Color fundus photograph:
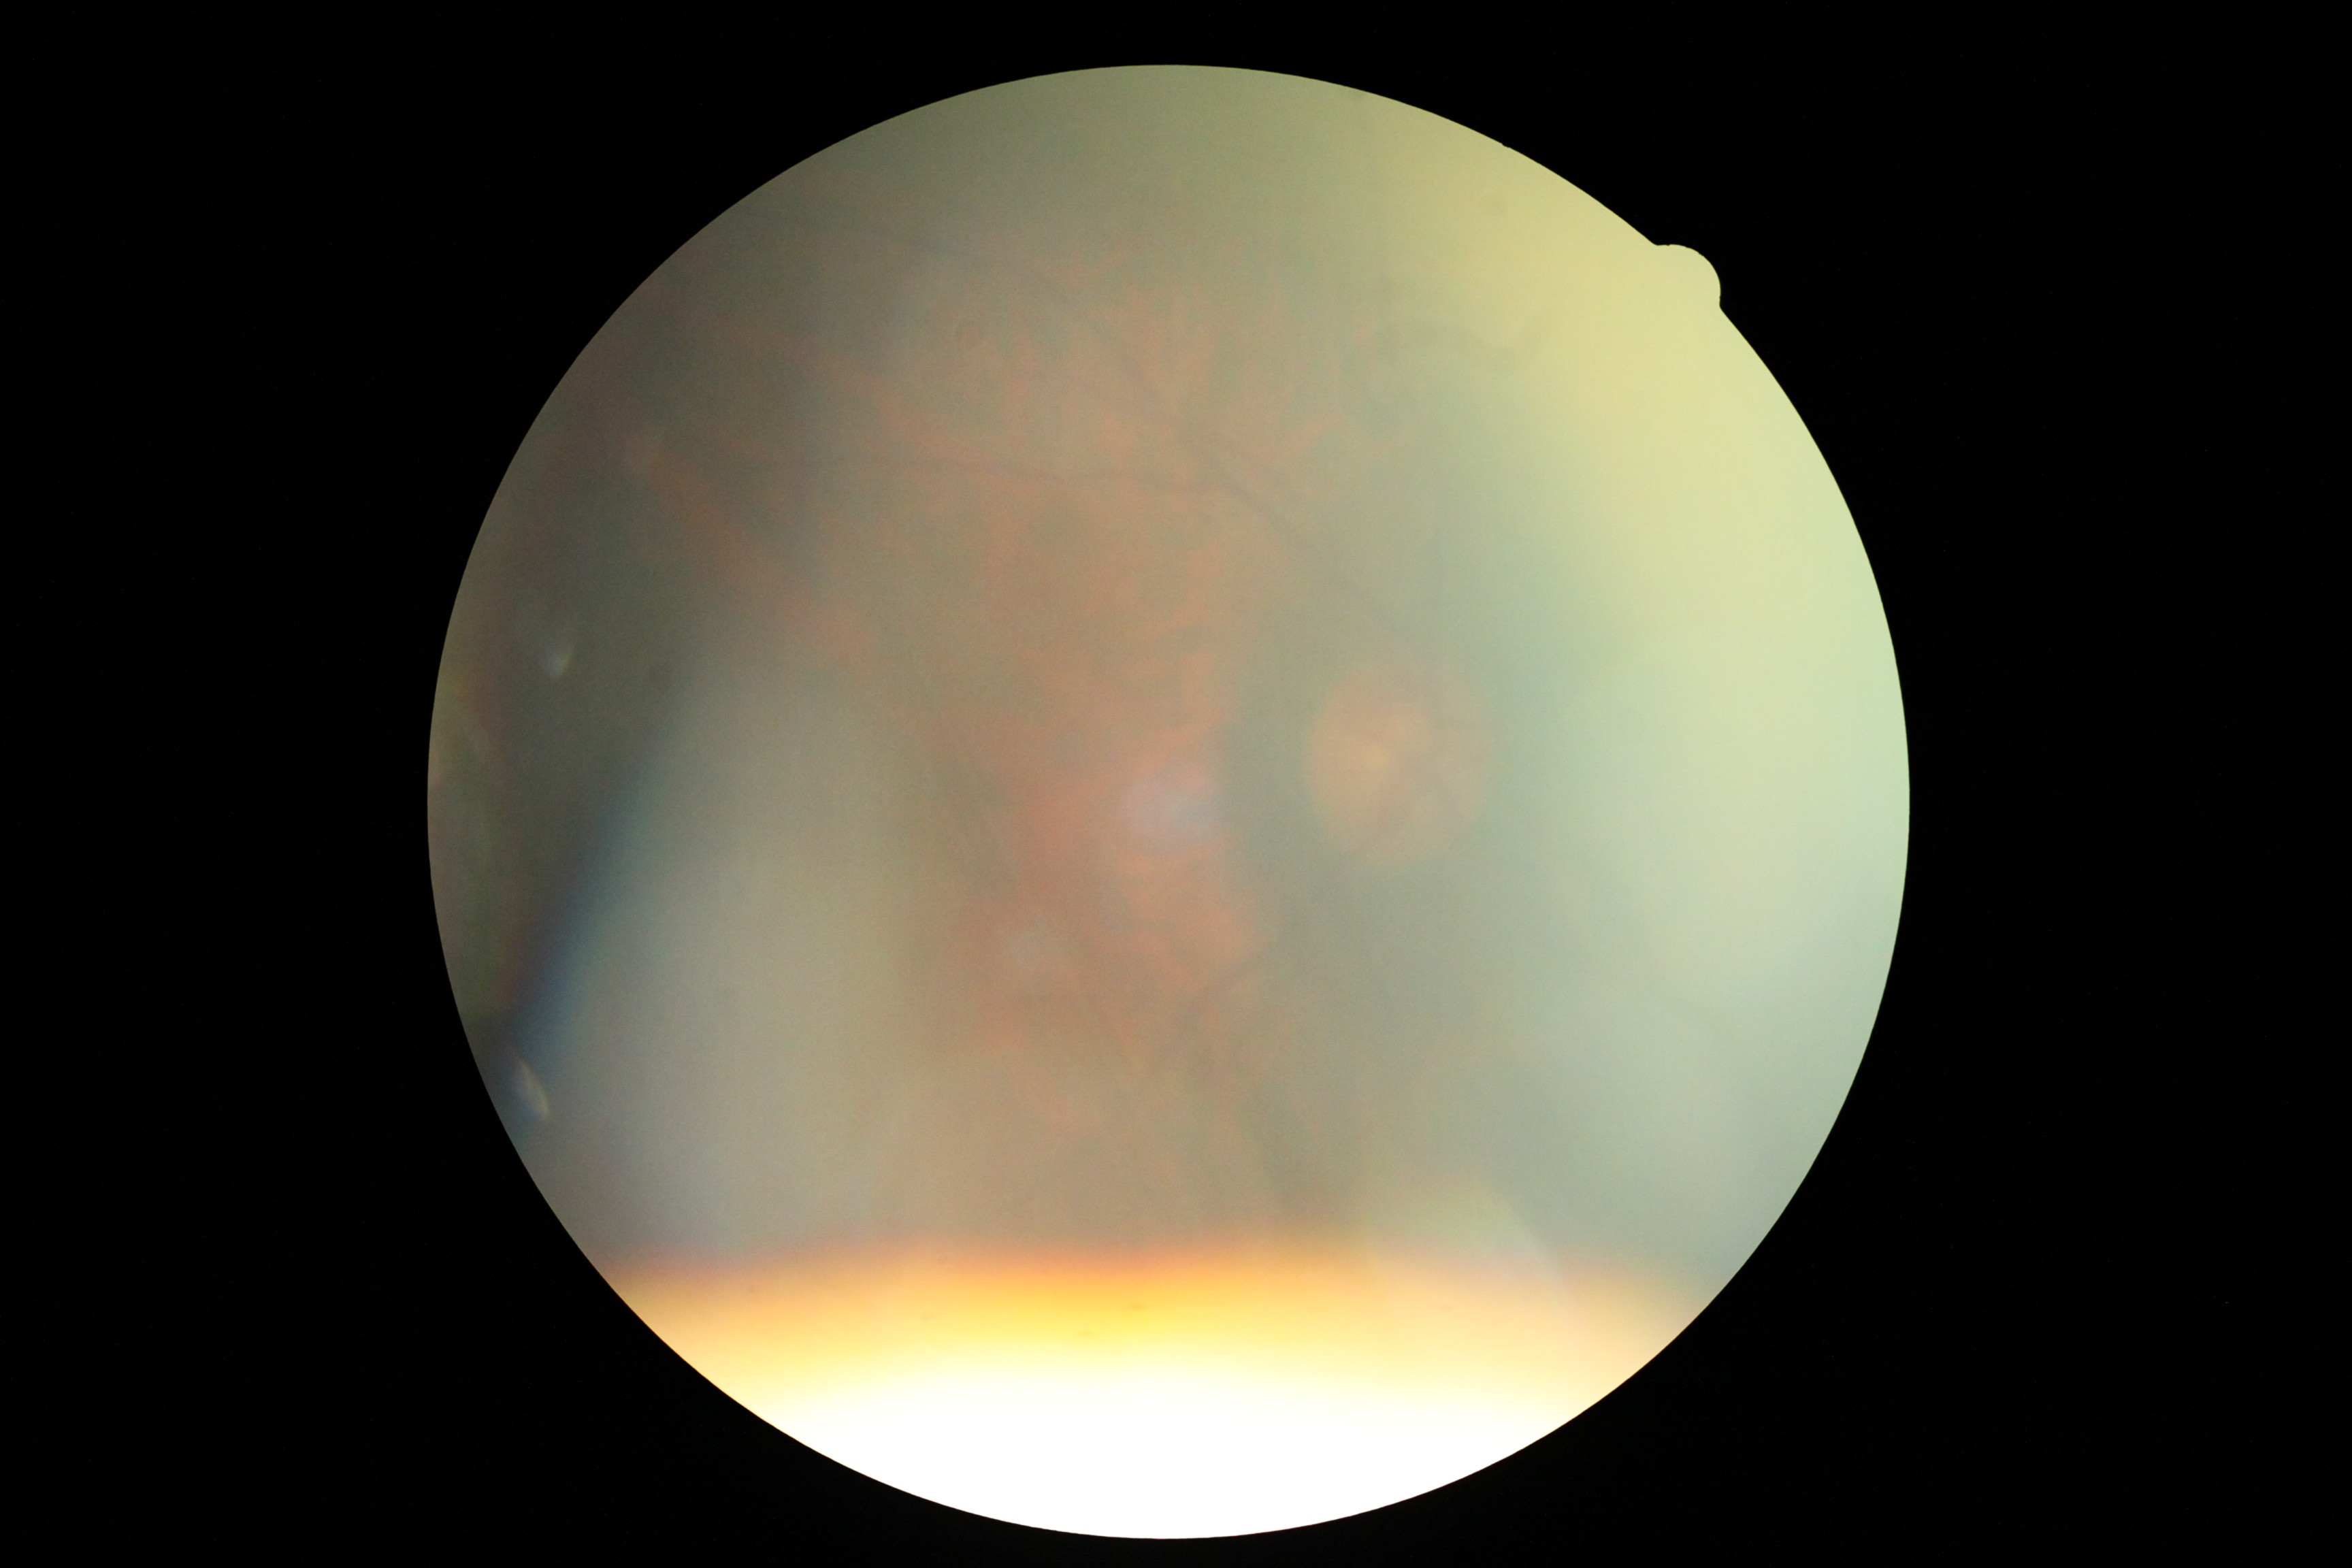 diabetic retinopathy (DR)@ungradable, image quality@insufficient.